1240x1240; wide-field fundus image from infant ROP screening; 100° field of view (Phoenix ICON)
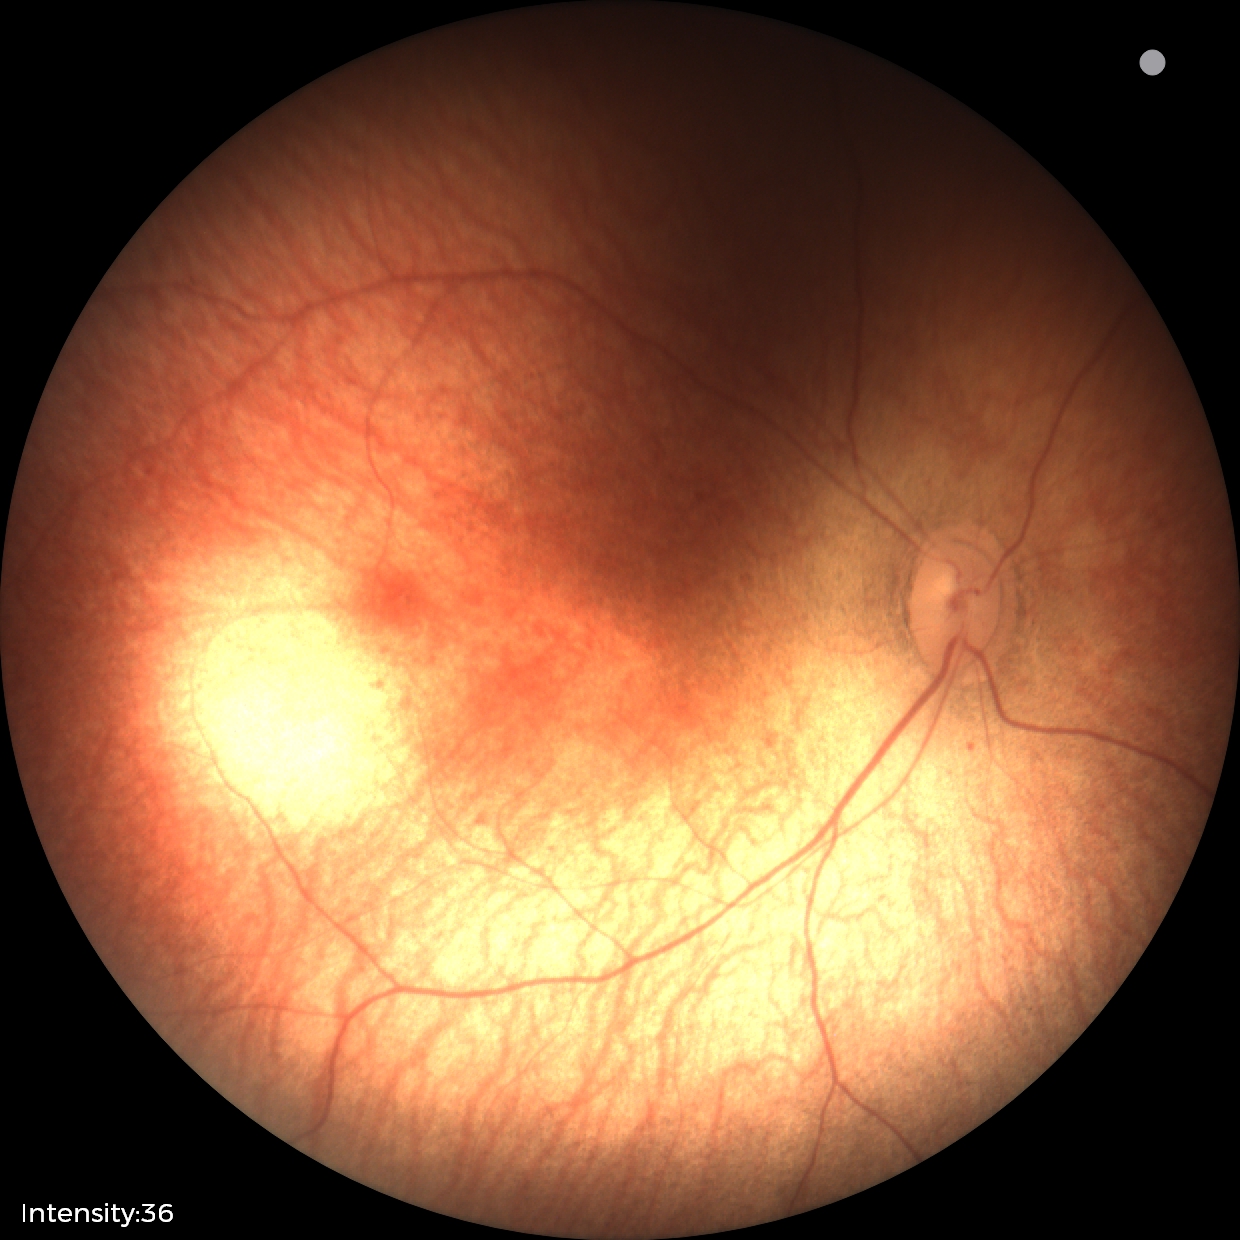 No retinal pathology identified on screening.